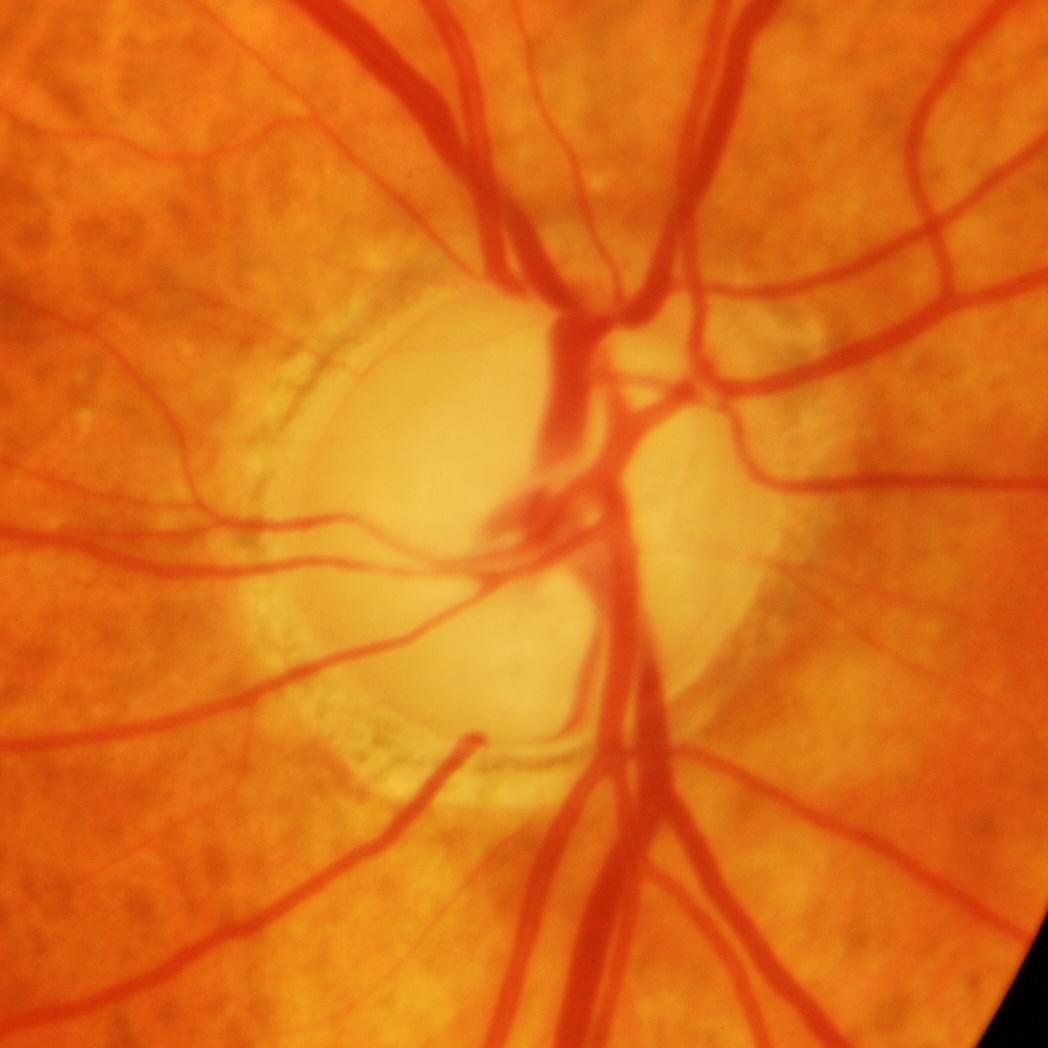
Finding: glaucomatous damage to the optic nerve.